Handheld portable fundus camera image: 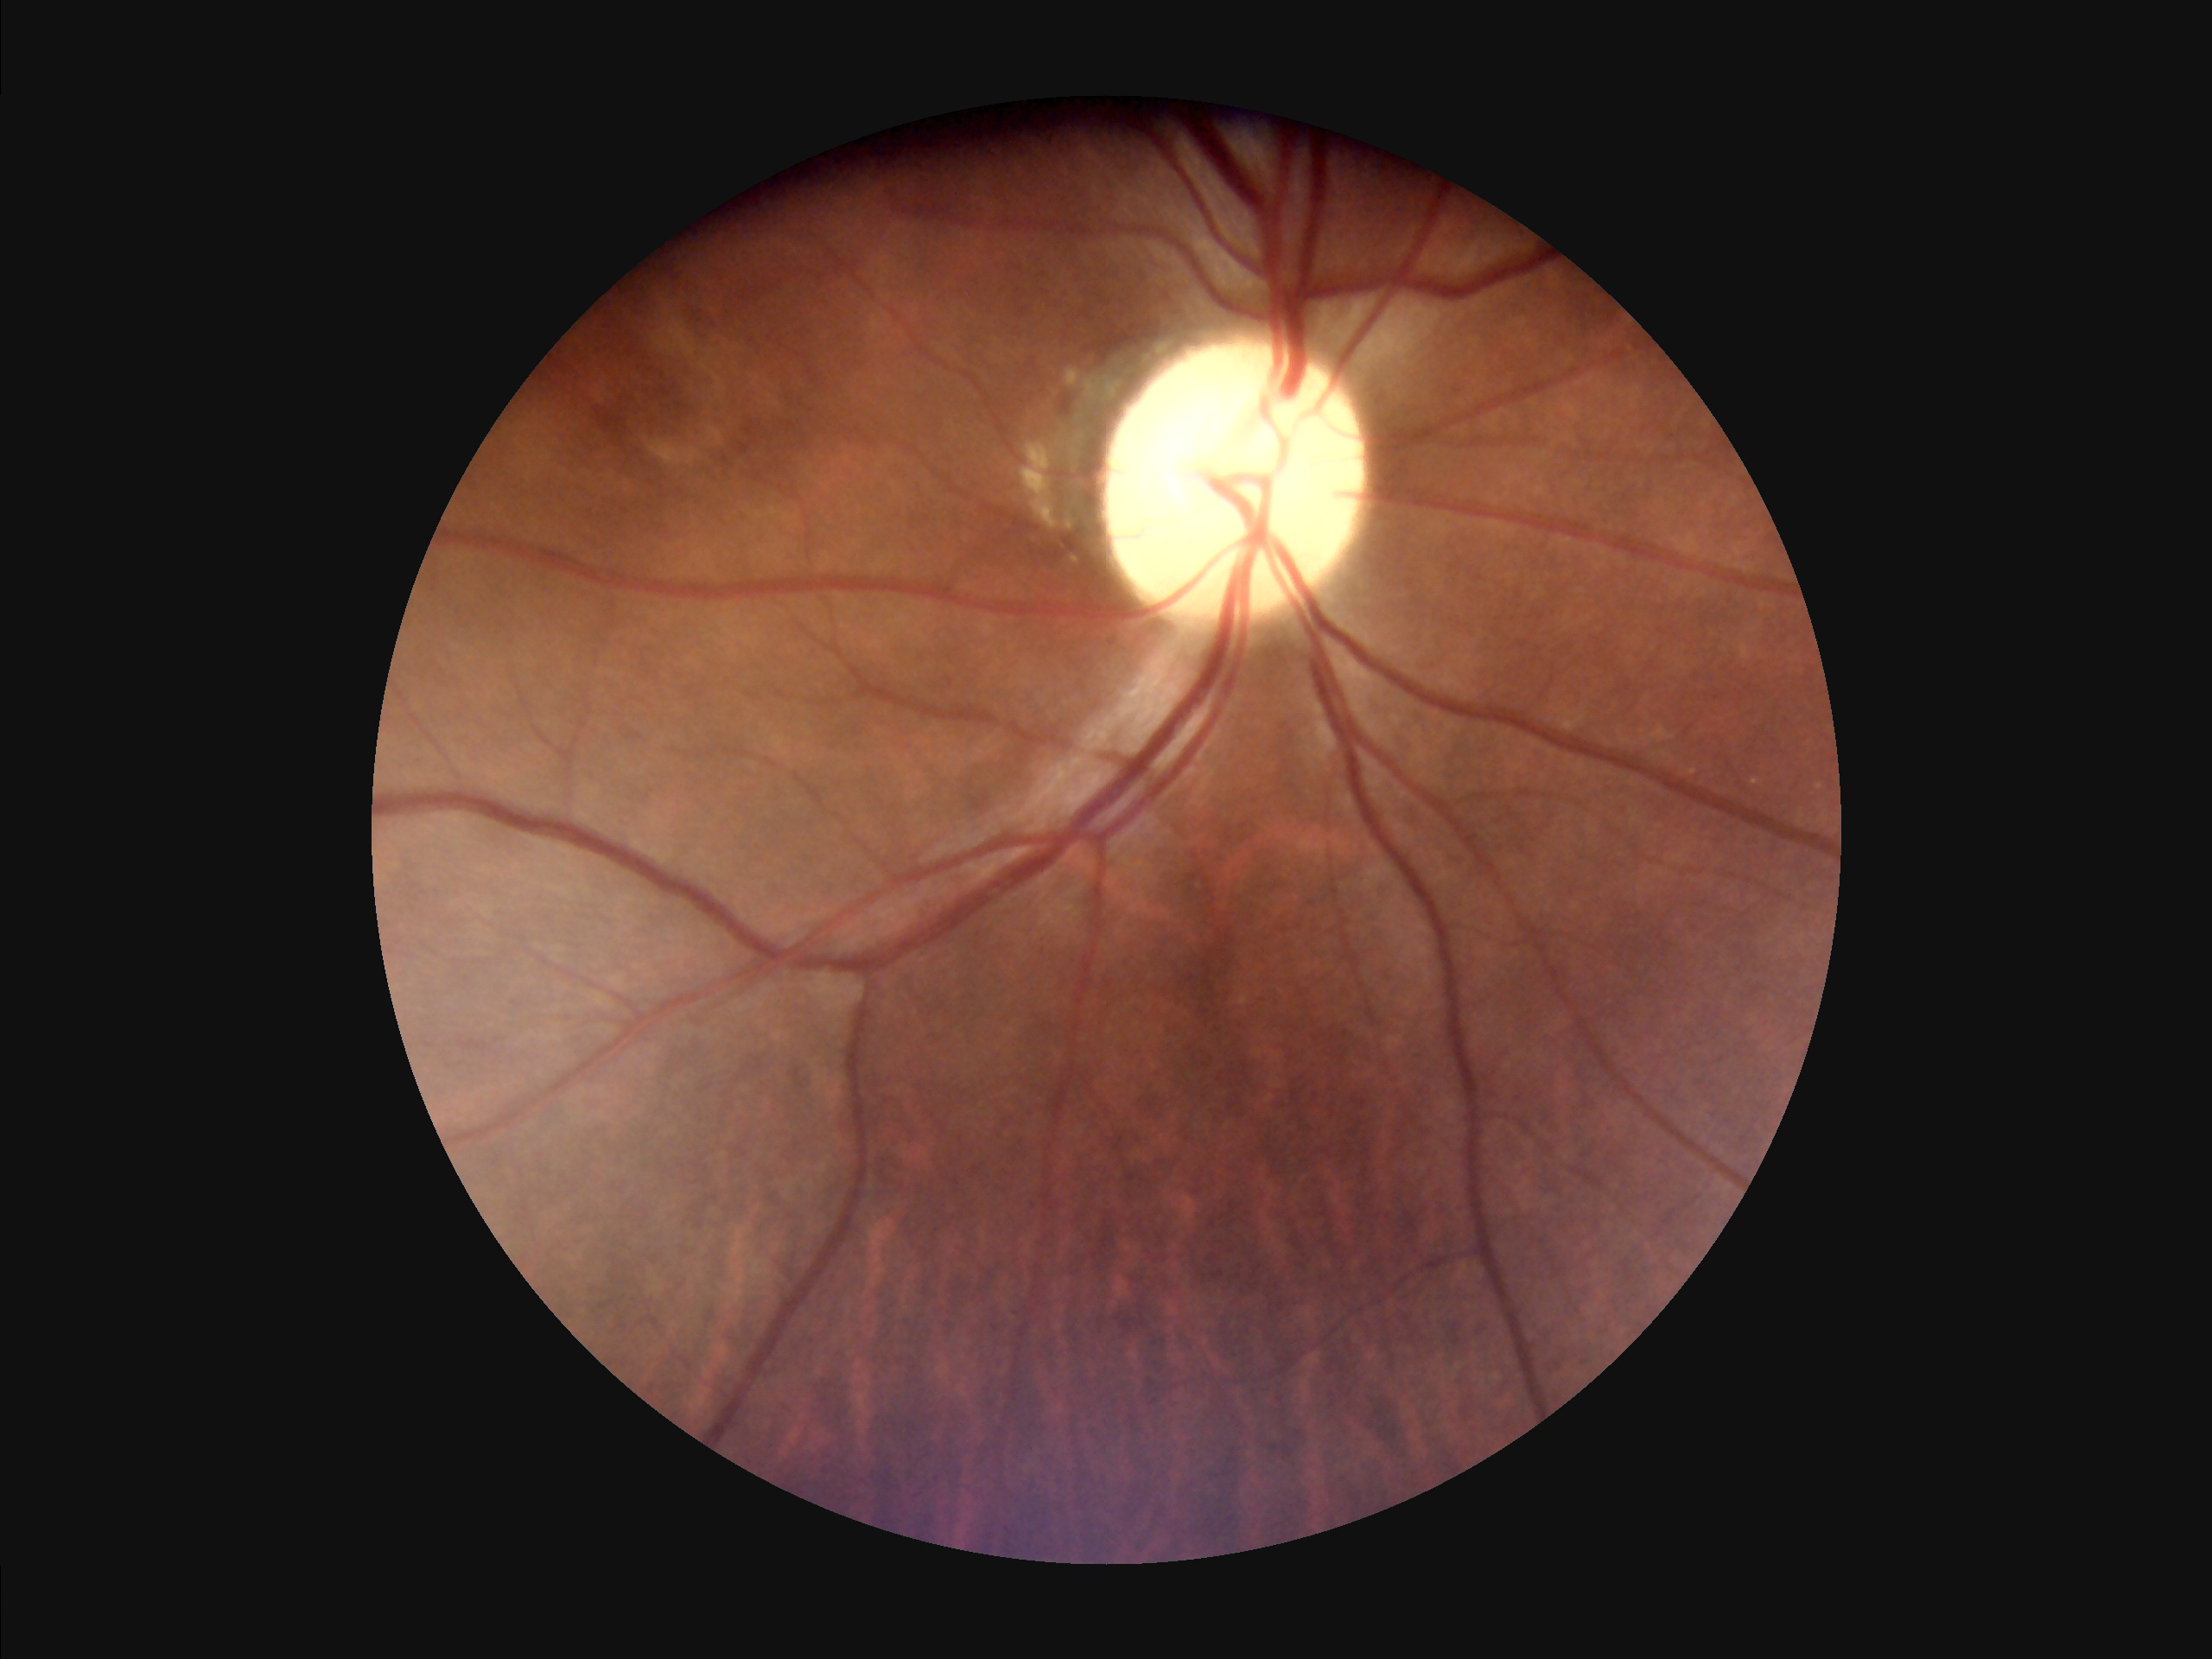

Quality grading: contrast: satisfactory | sharpness: clear | overall: satisfactory | illumination/color: even.